1240x1240px · wide-field contact fundus photograph of an infant: 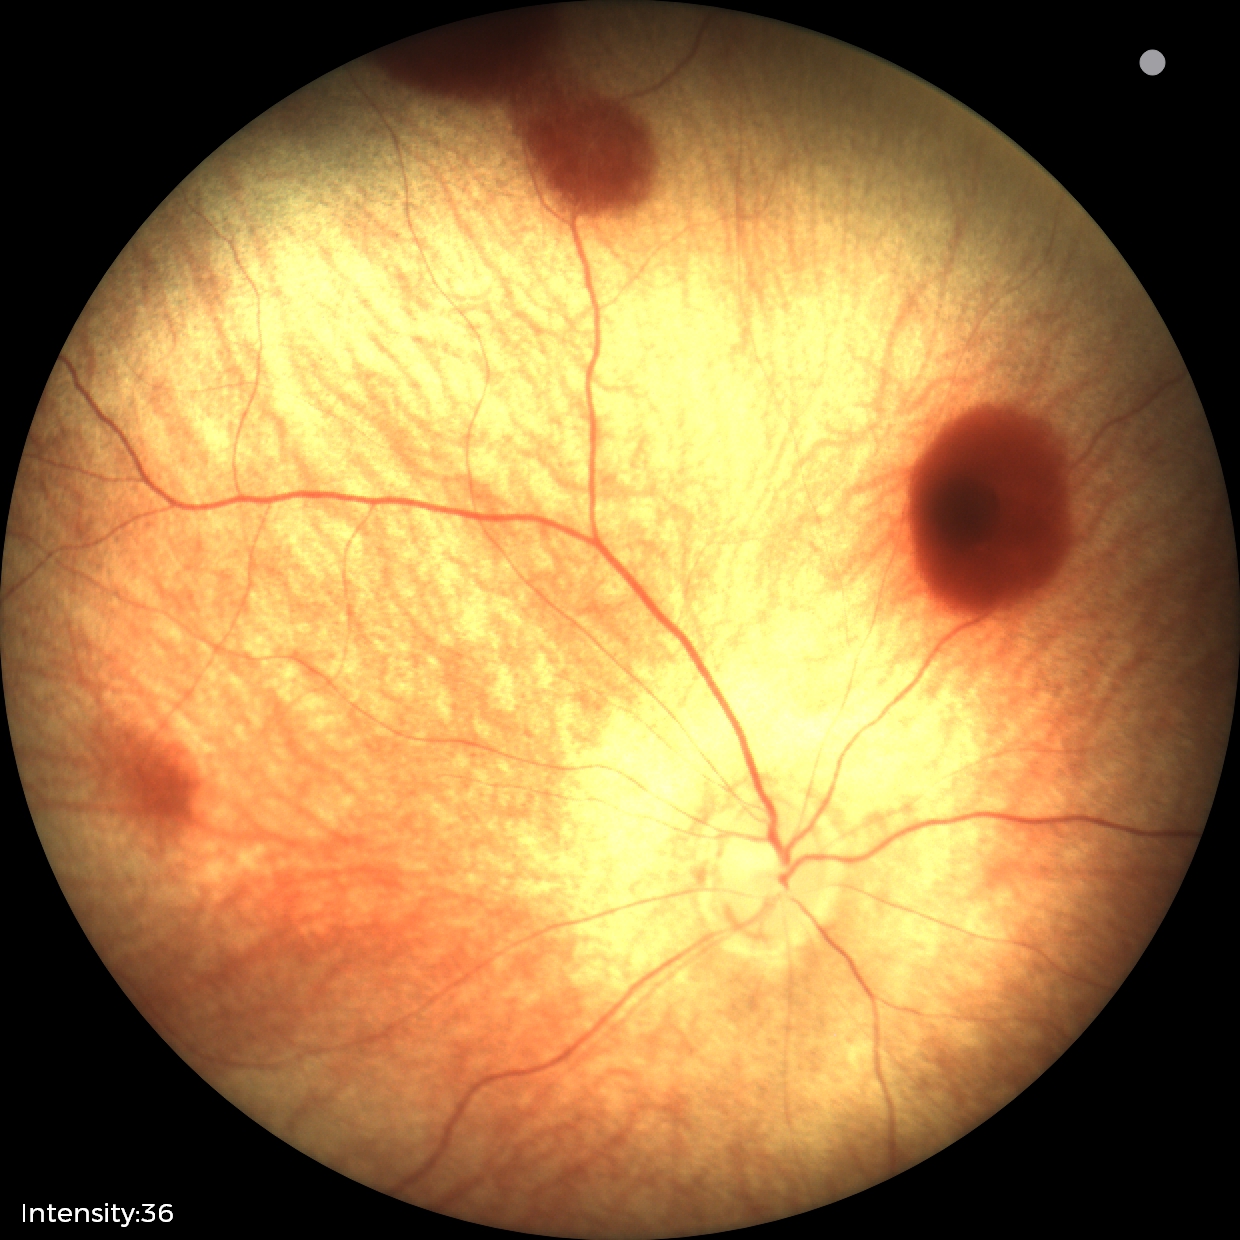
Series diagnosed as retinal hemorrhages.